FOV: 45 degrees:
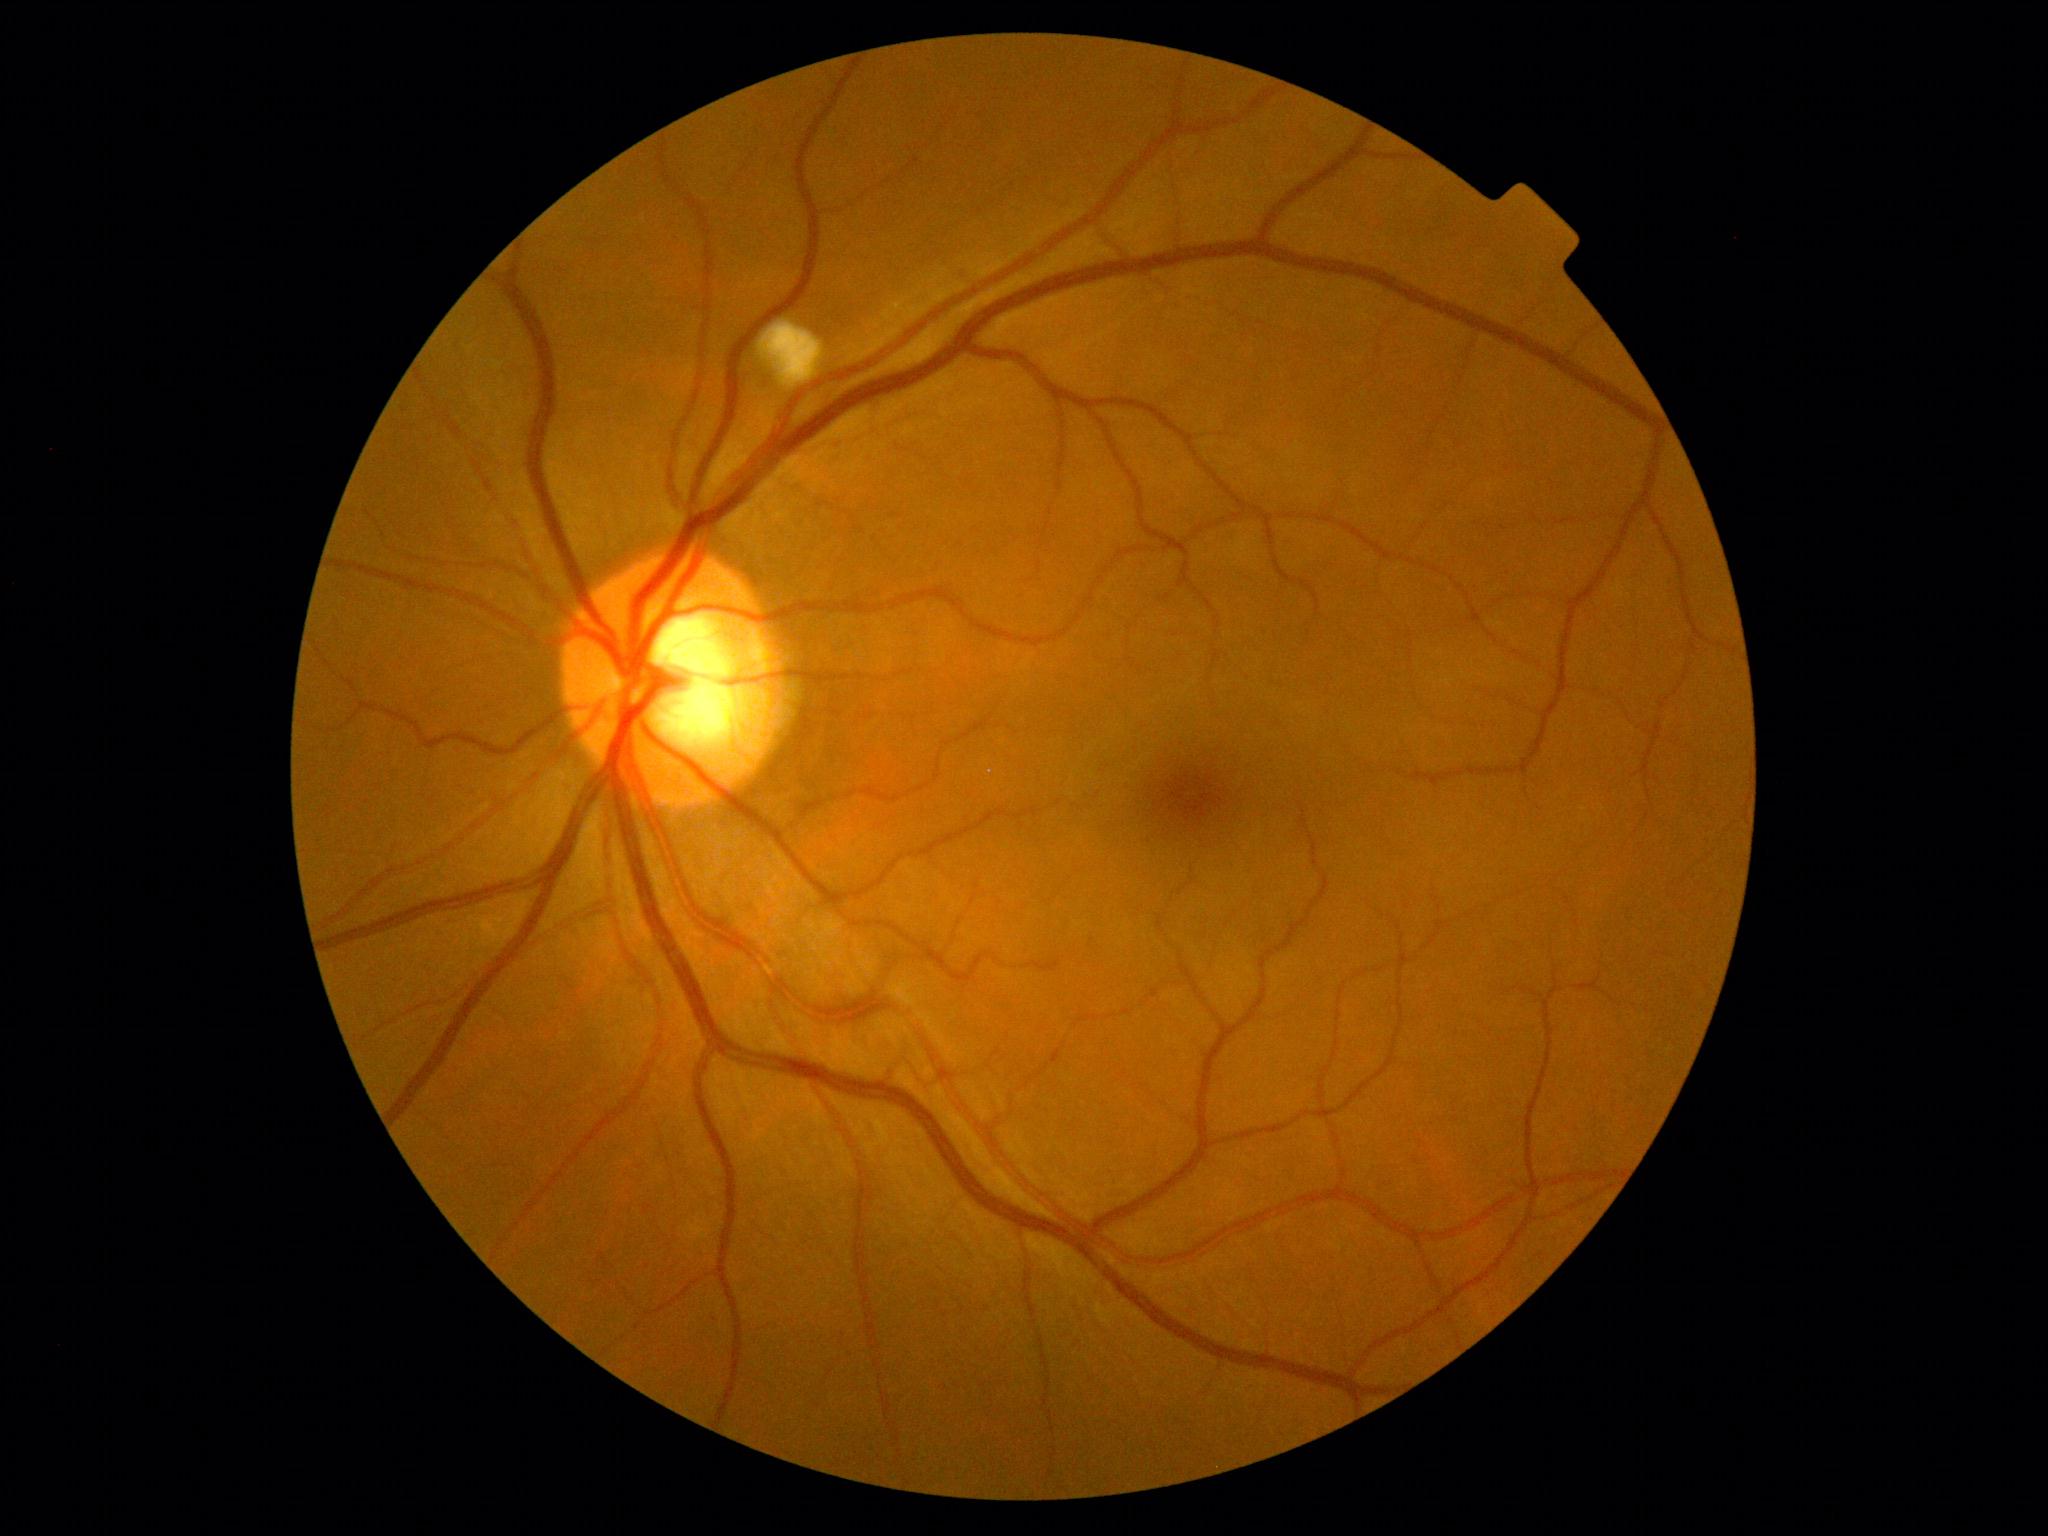 Findings:
• retinopathy grade — 2 (moderate NPDR) — more than just microaneurysms but less than severe NPDR